2102 by 1736 pixels. Color fundus image — 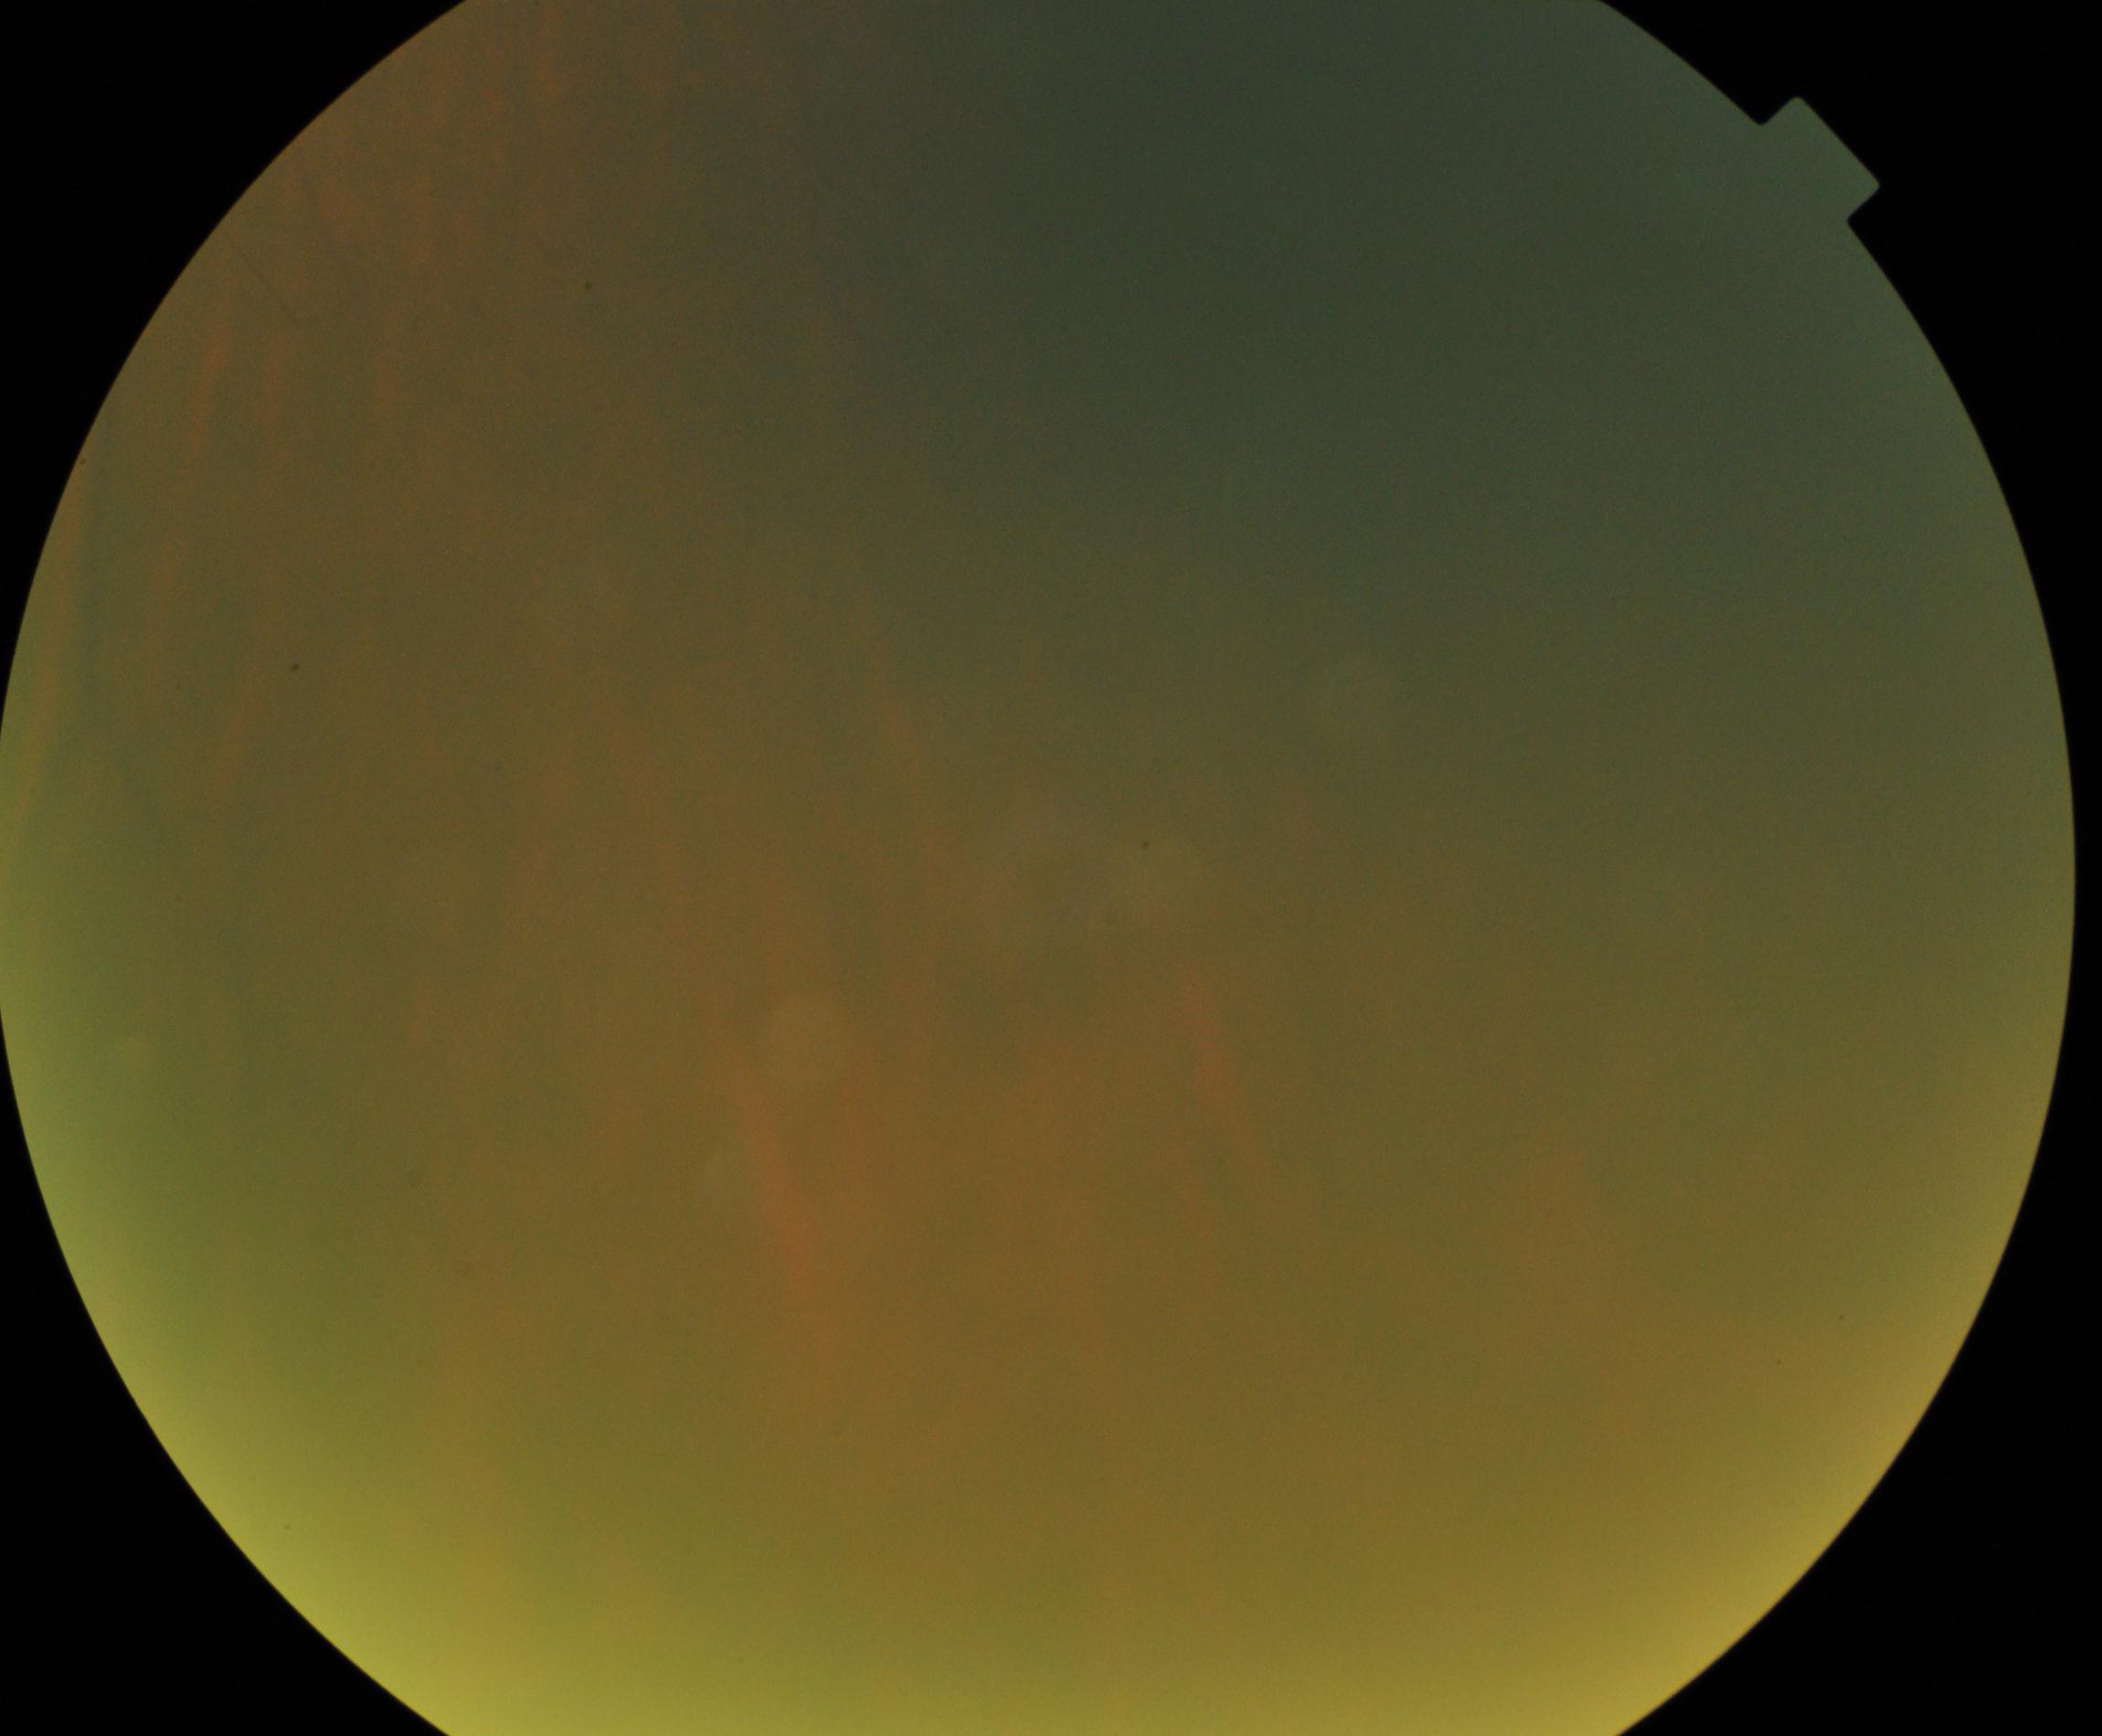
Gradability: poor. Proliferative diabetic retinopathy: no evidence.